Wide-field fundus image from infant ROP screening
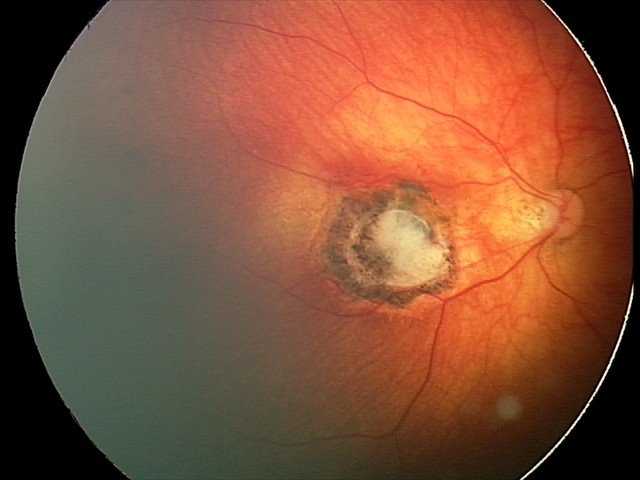
Examination diagnosed as toxoplasmosis chorioretinitis.